Davis DR grading; retinal fundus photograph:
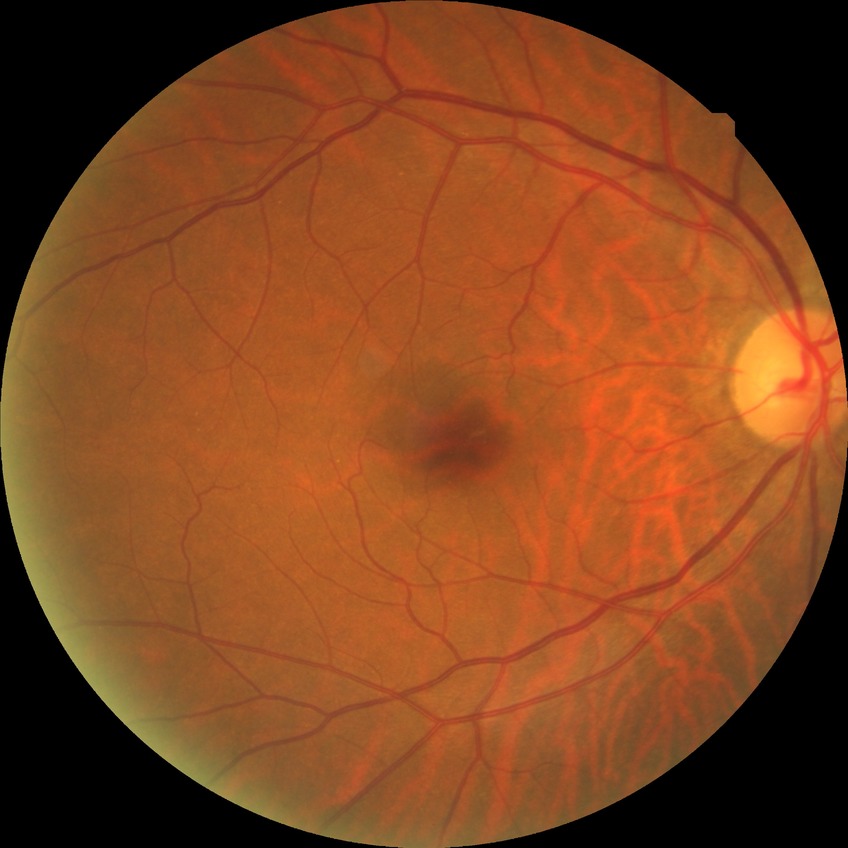 Modified Davis classification is no diabetic retinopathy.